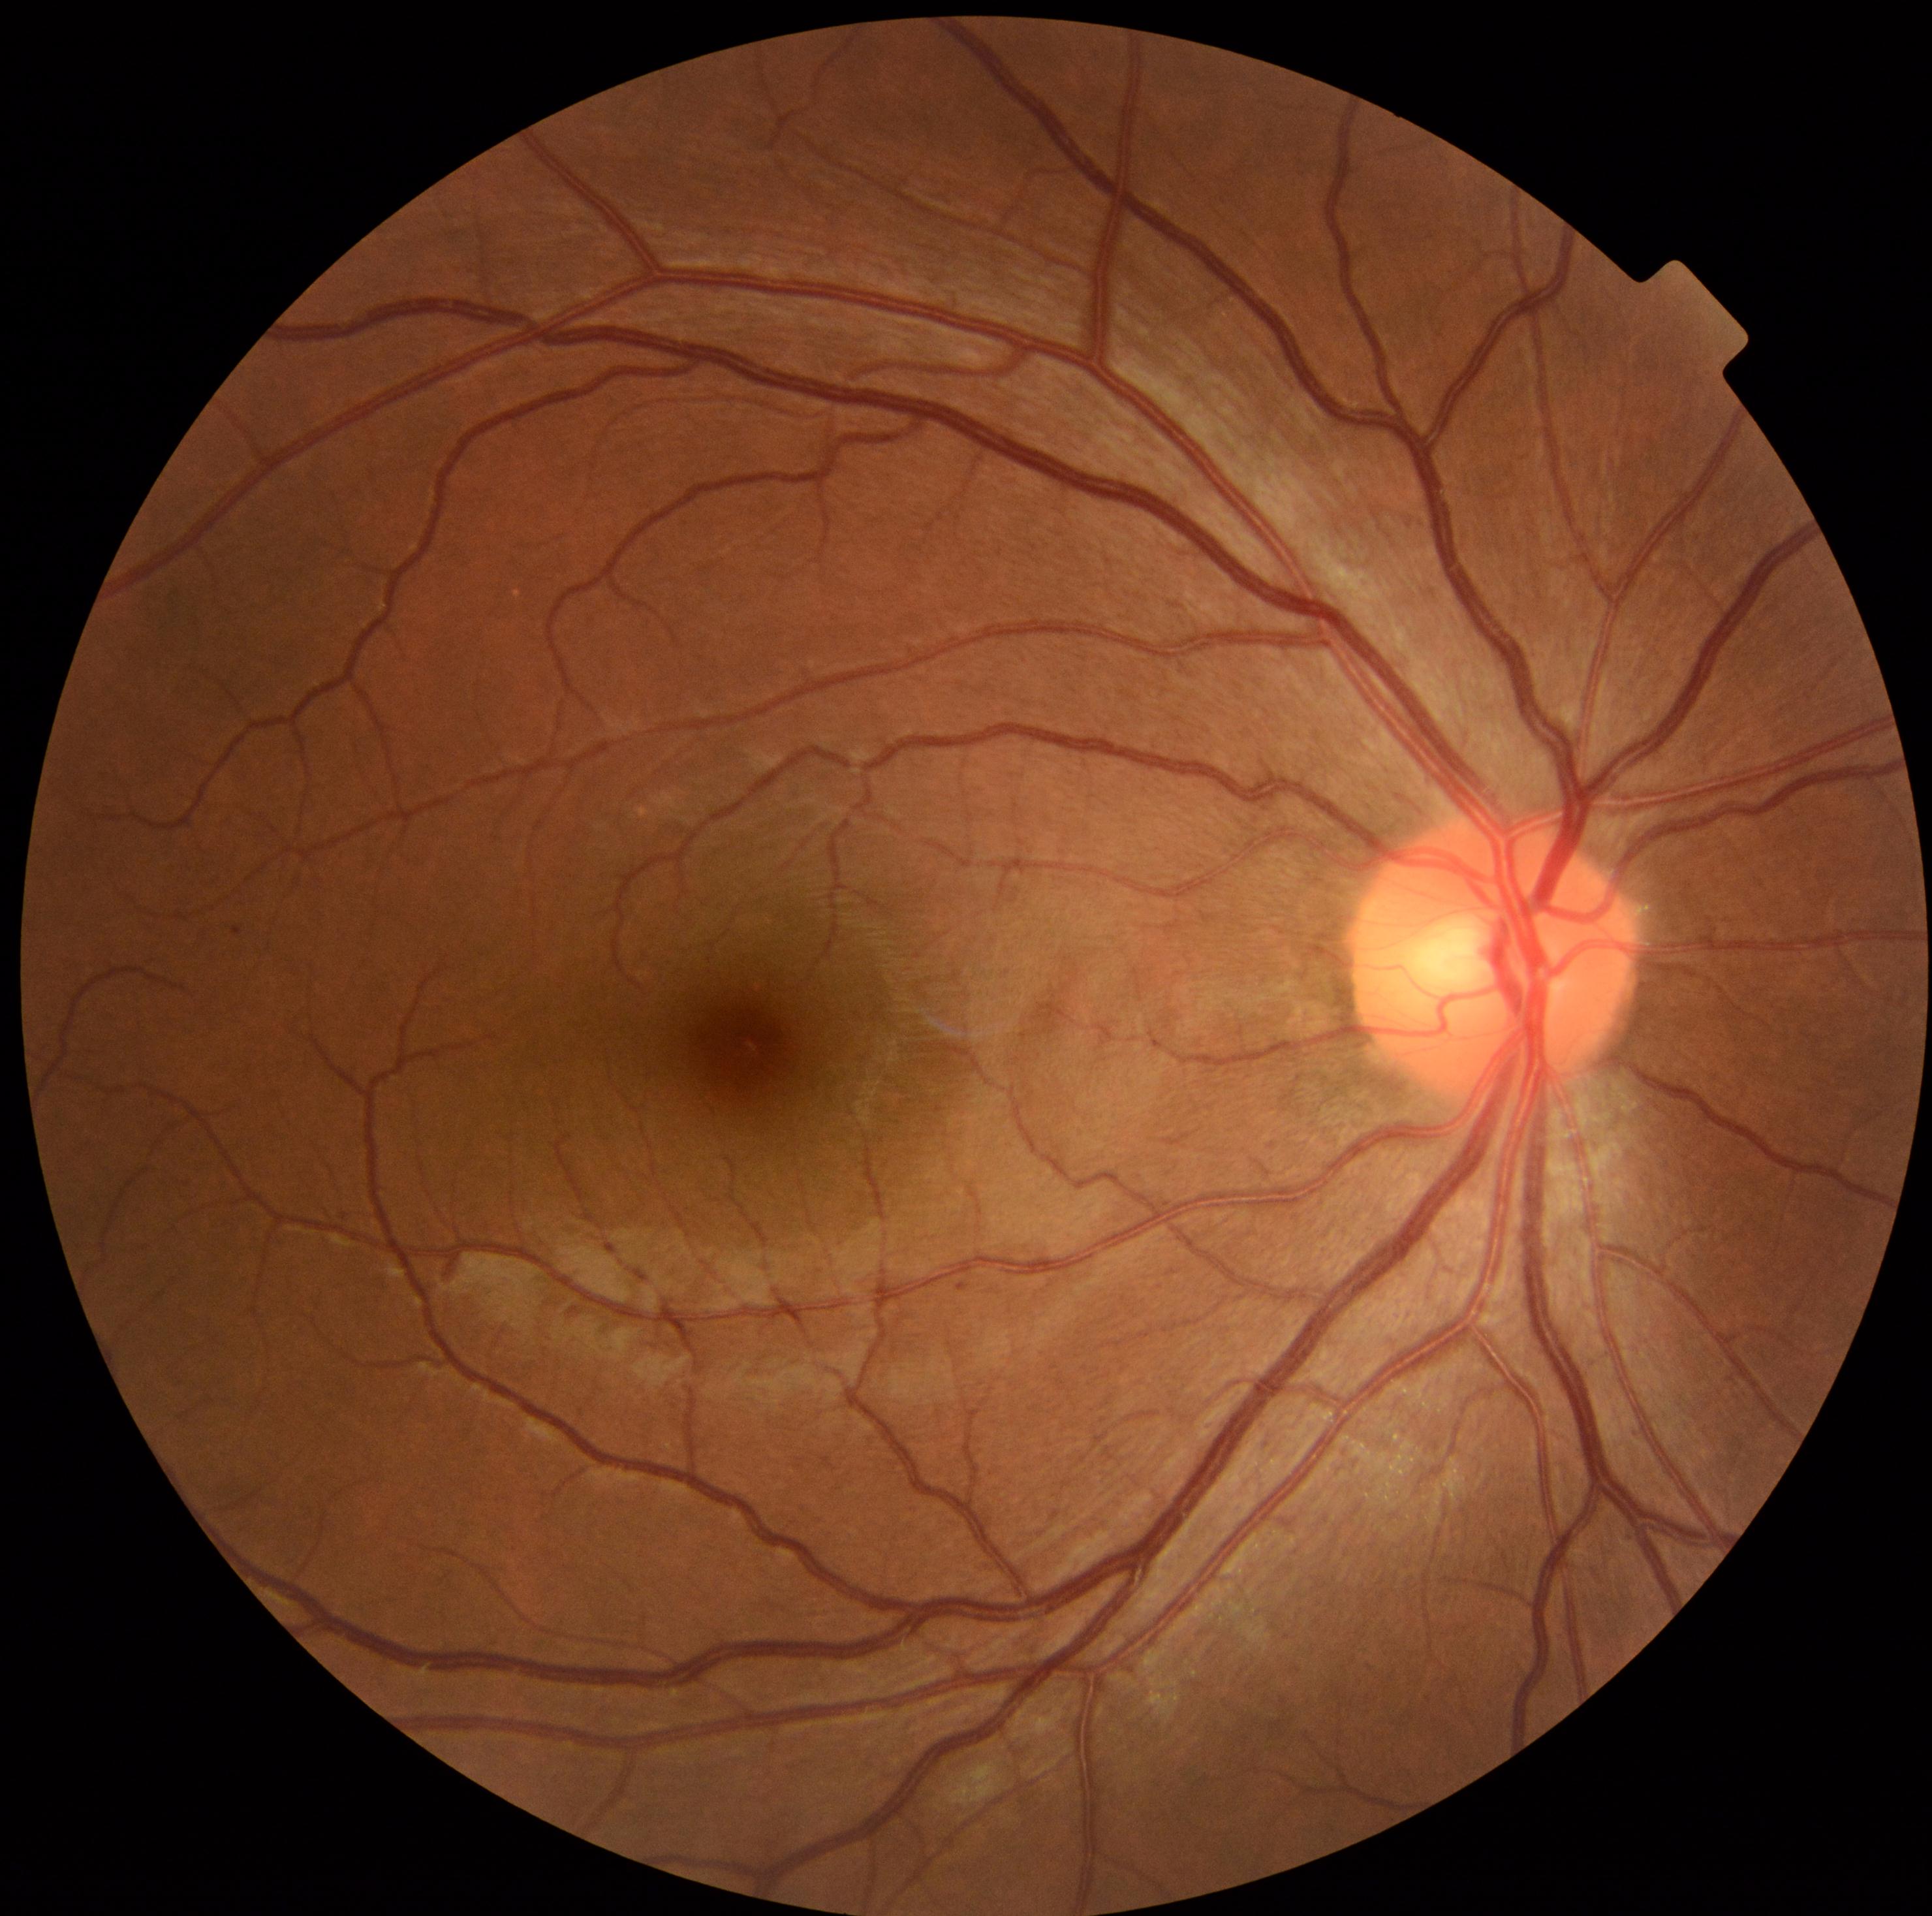 {
  "dr_grade": "mild NPDR (1)"
}